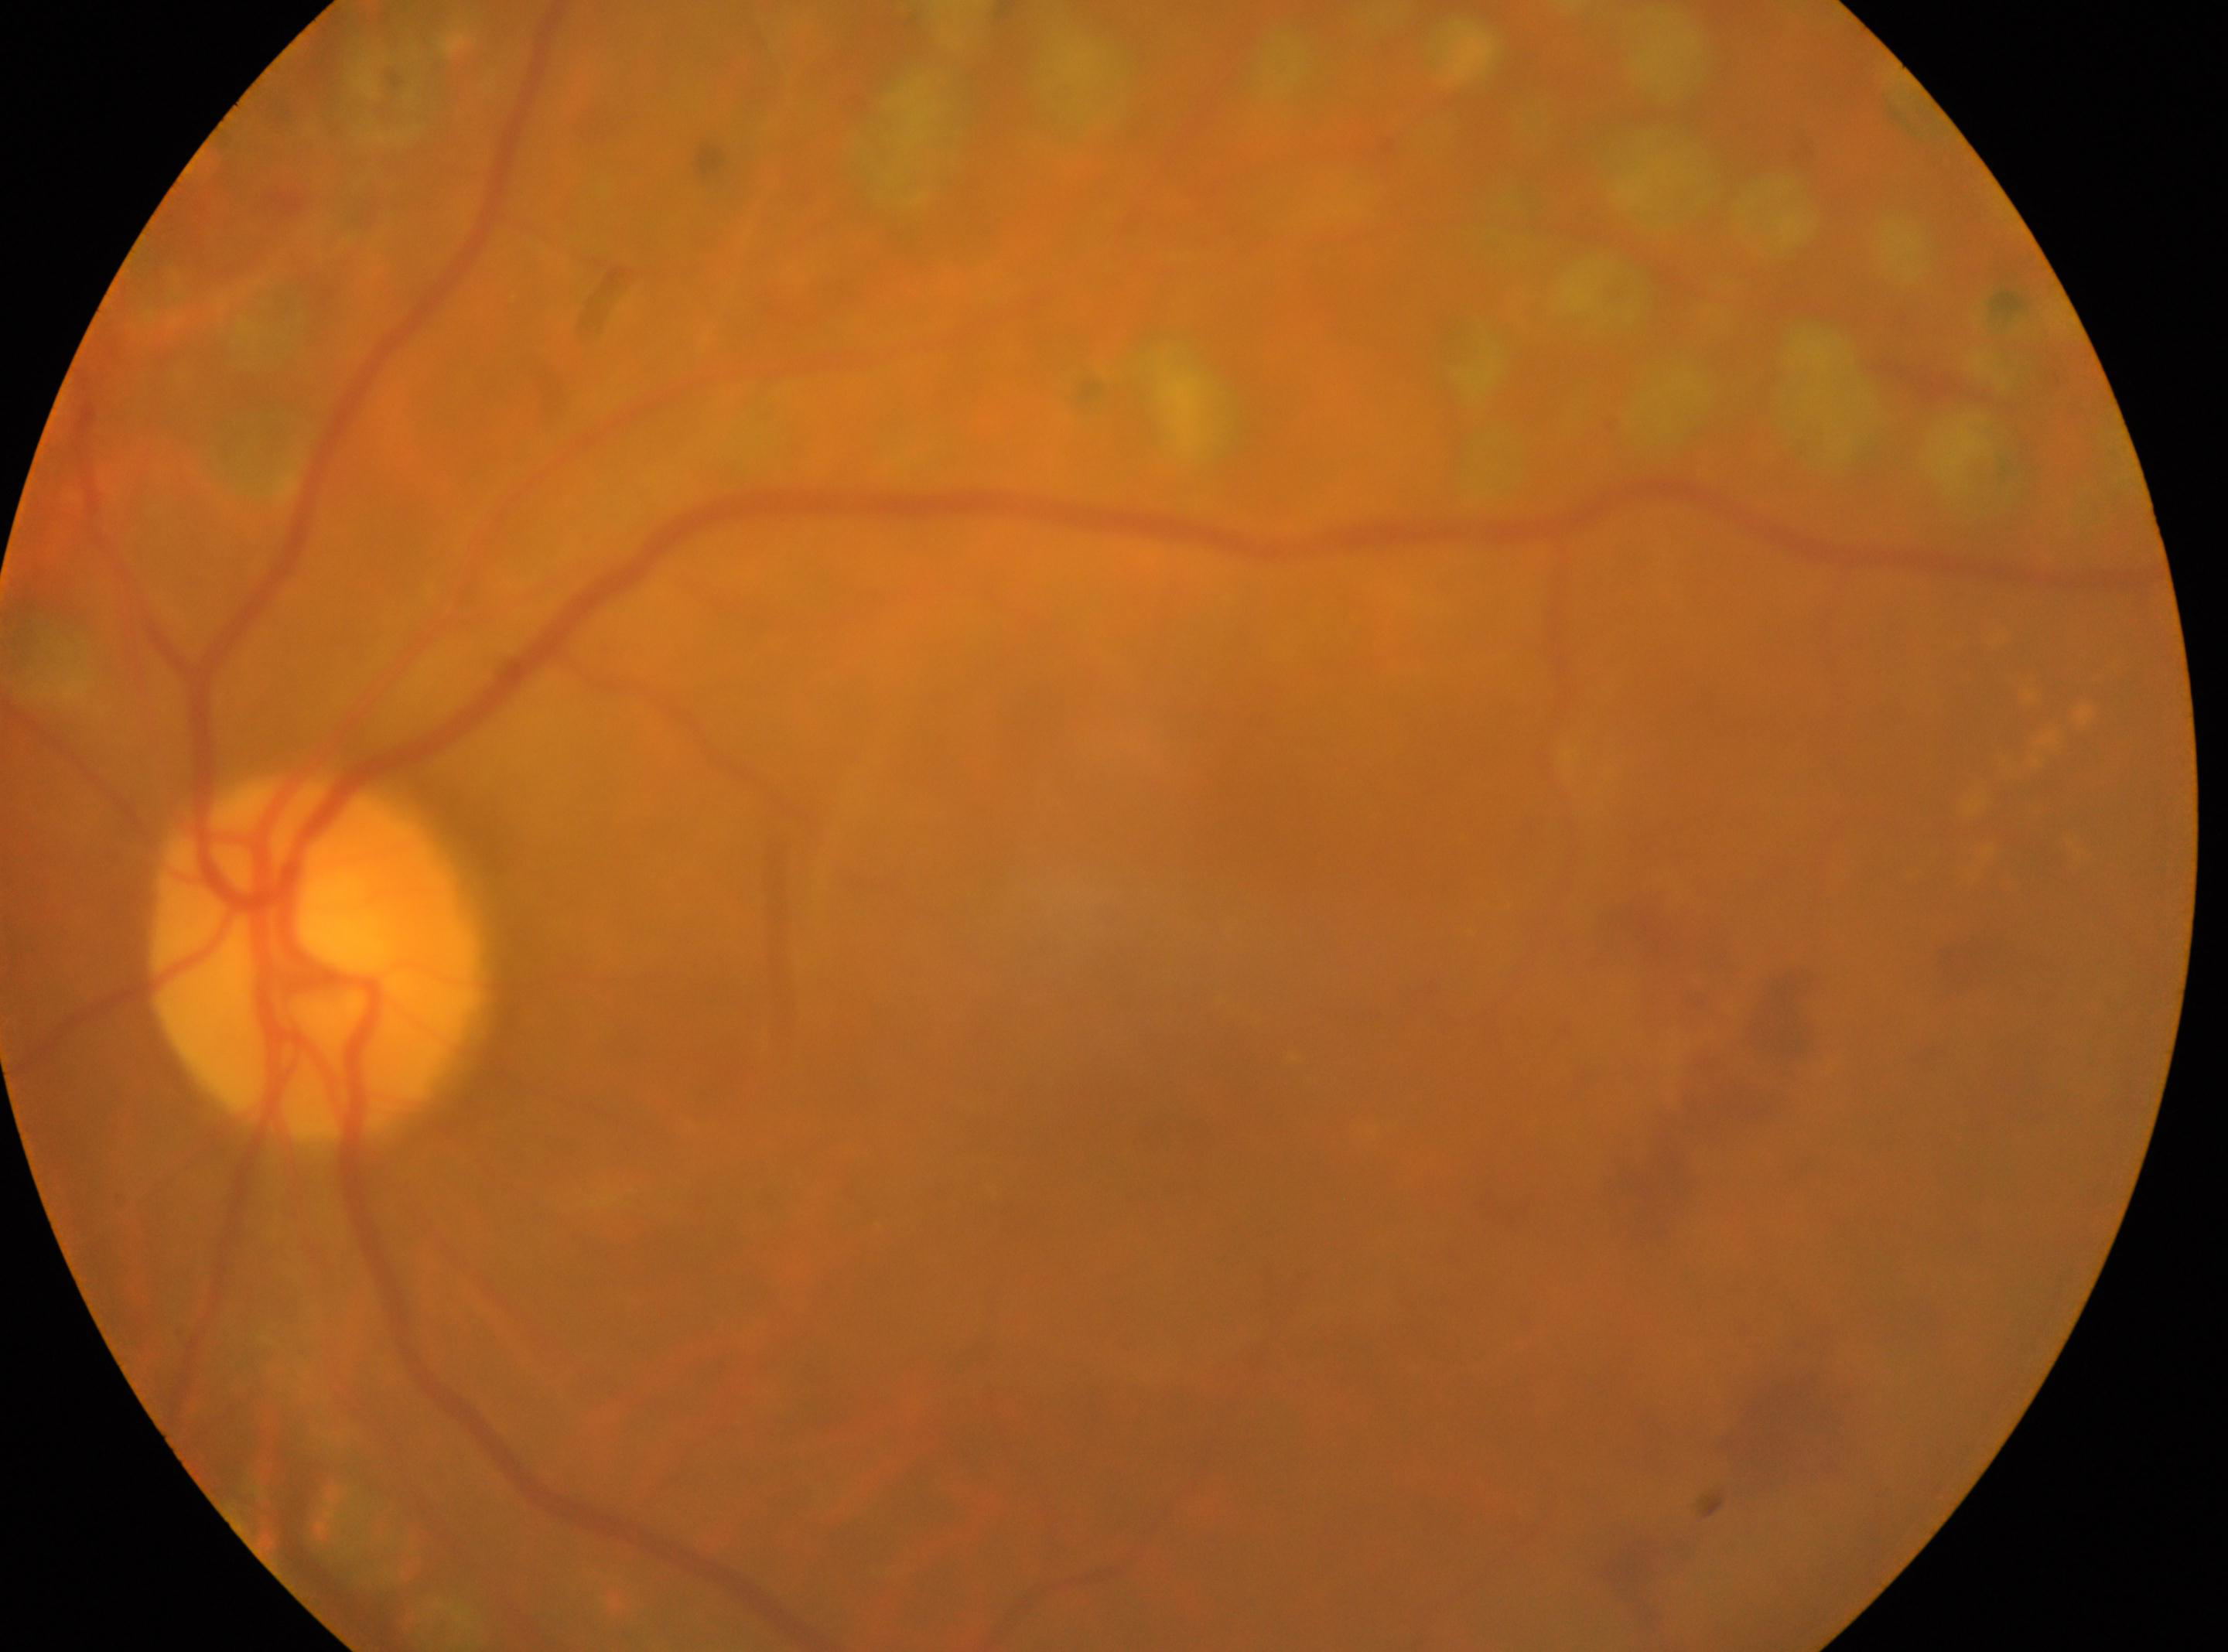
OS
foveal center=1165px, 1111px
retinopathy=DR with laser photocoagulation scars, with underlying moderate non-proliferative diabetic retinopathy (grade 2)
disc center=314px, 957px